Handheld portable fundus camera image — 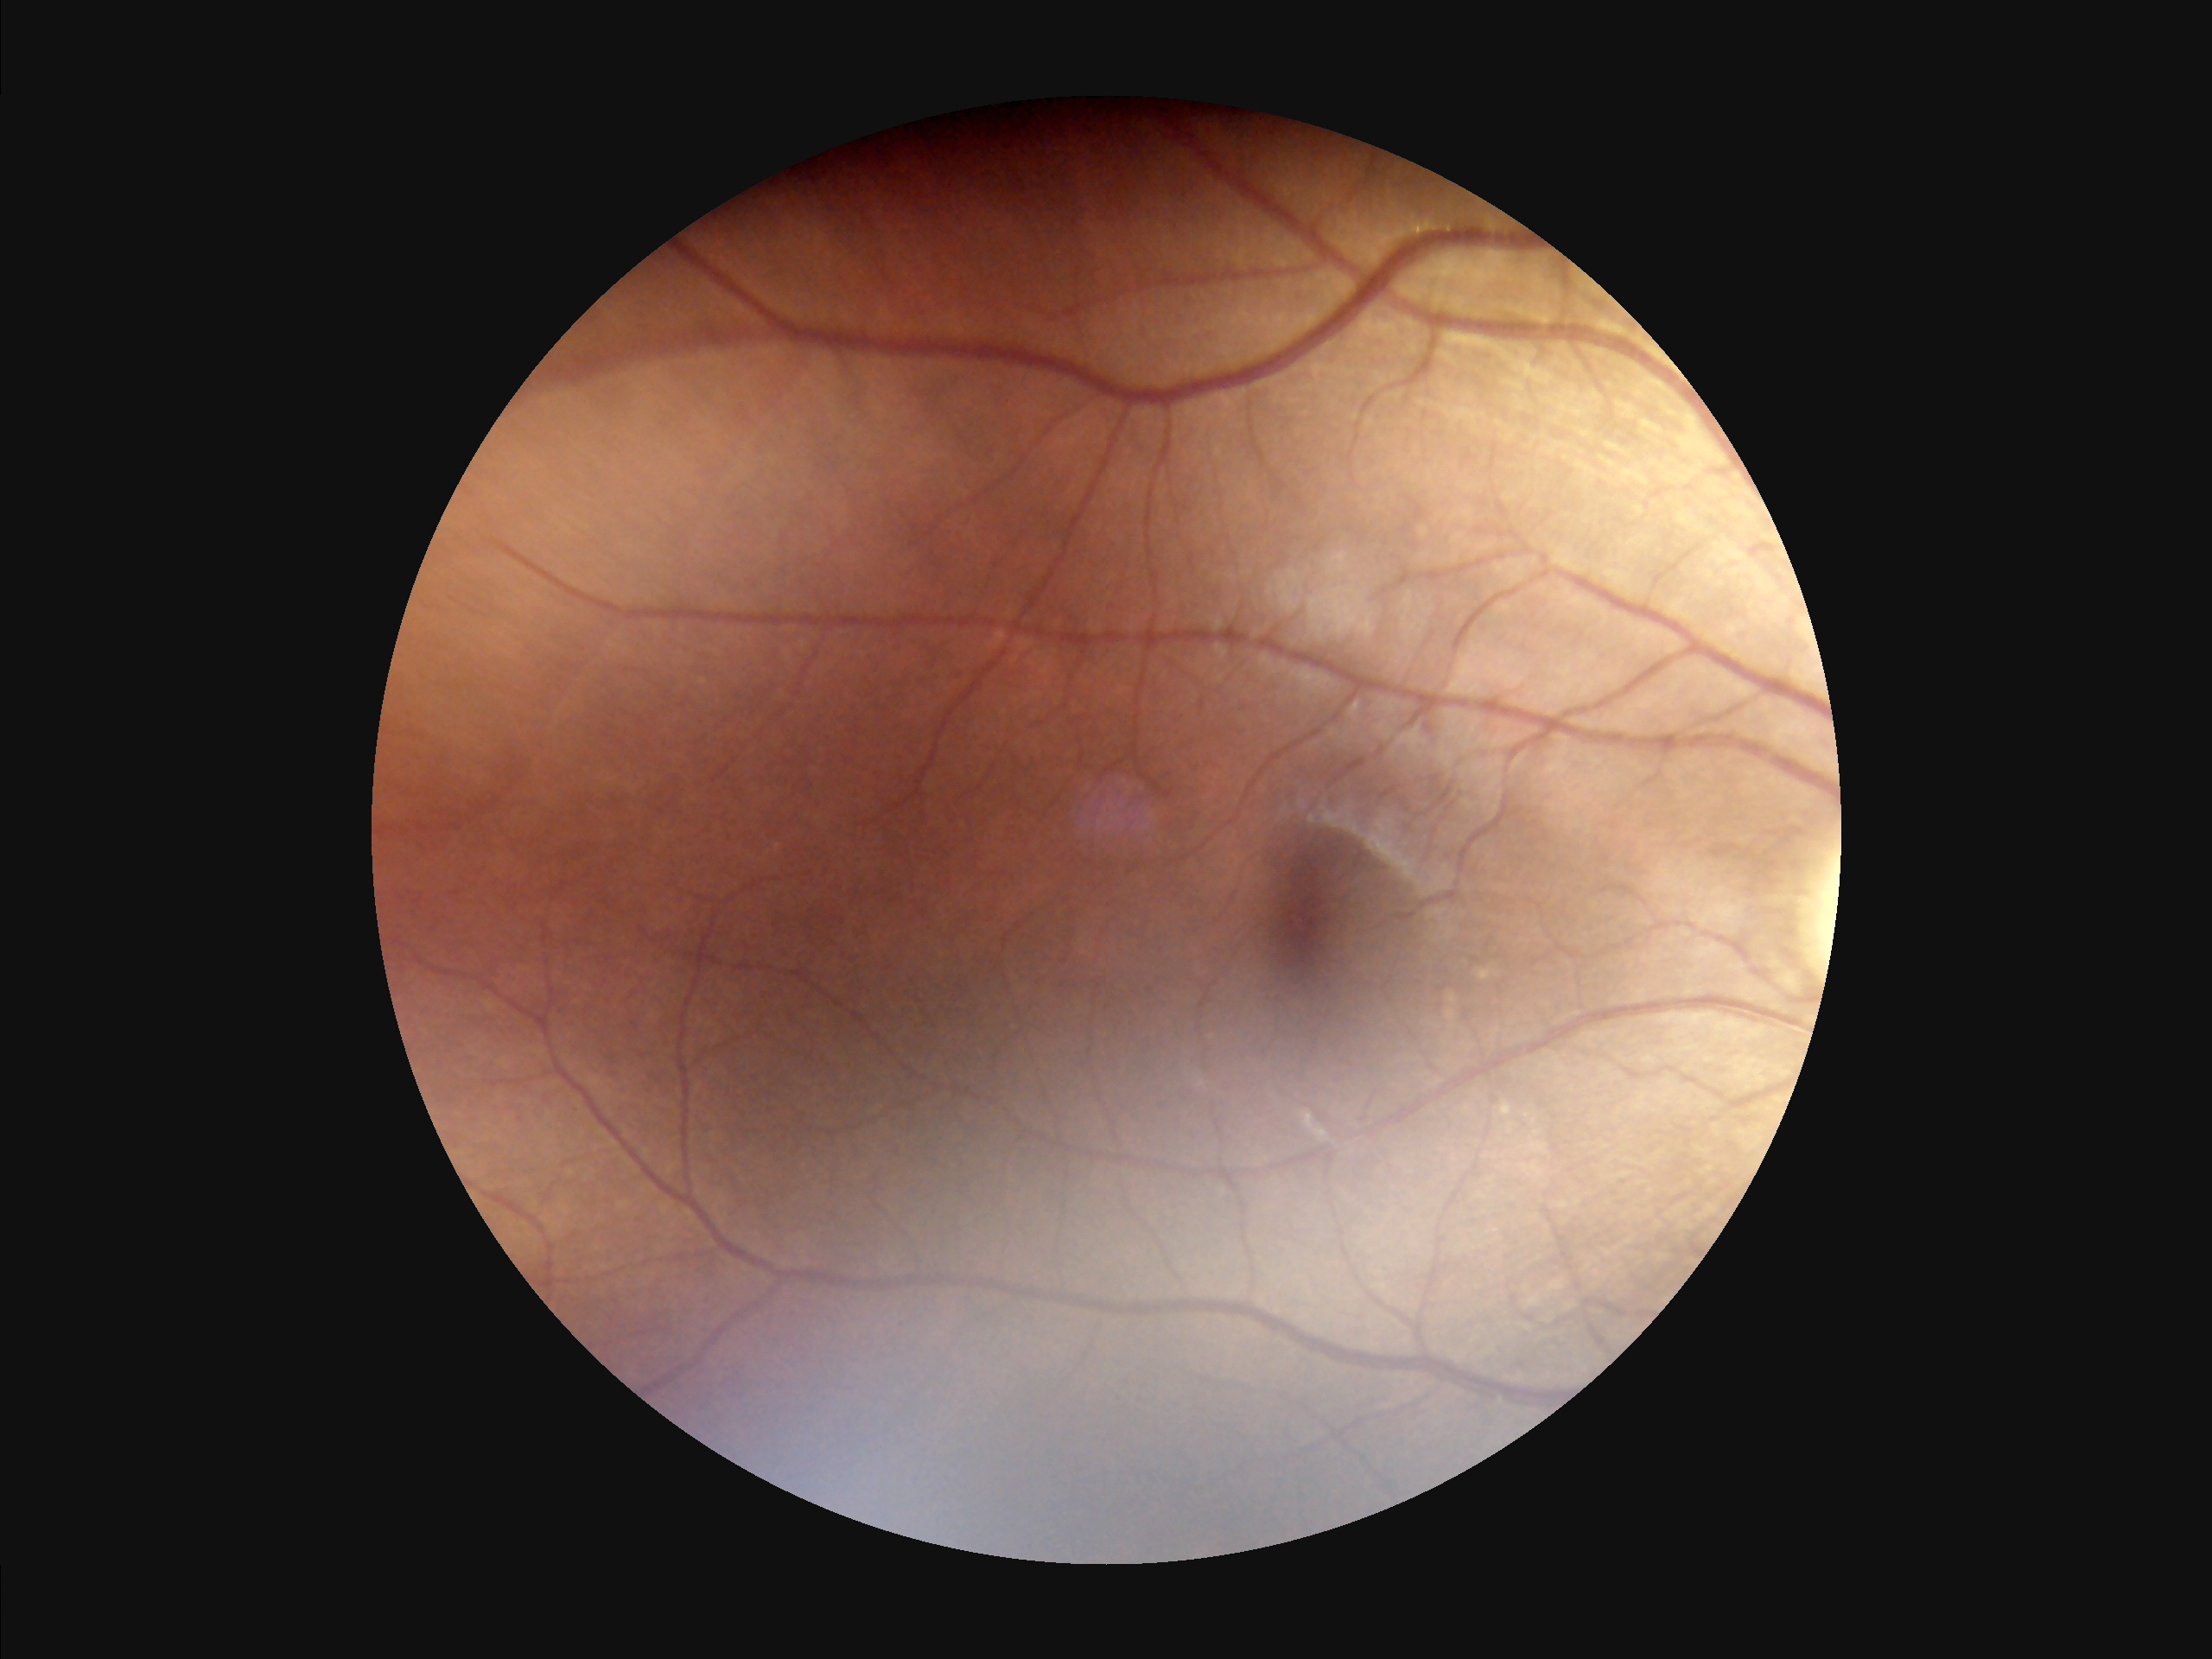

No noticeable blur. Illumination and color are suboptimal. Overall quality is good and the image is gradable. Adequate contrast for distinguishing structures.